Color fundus image
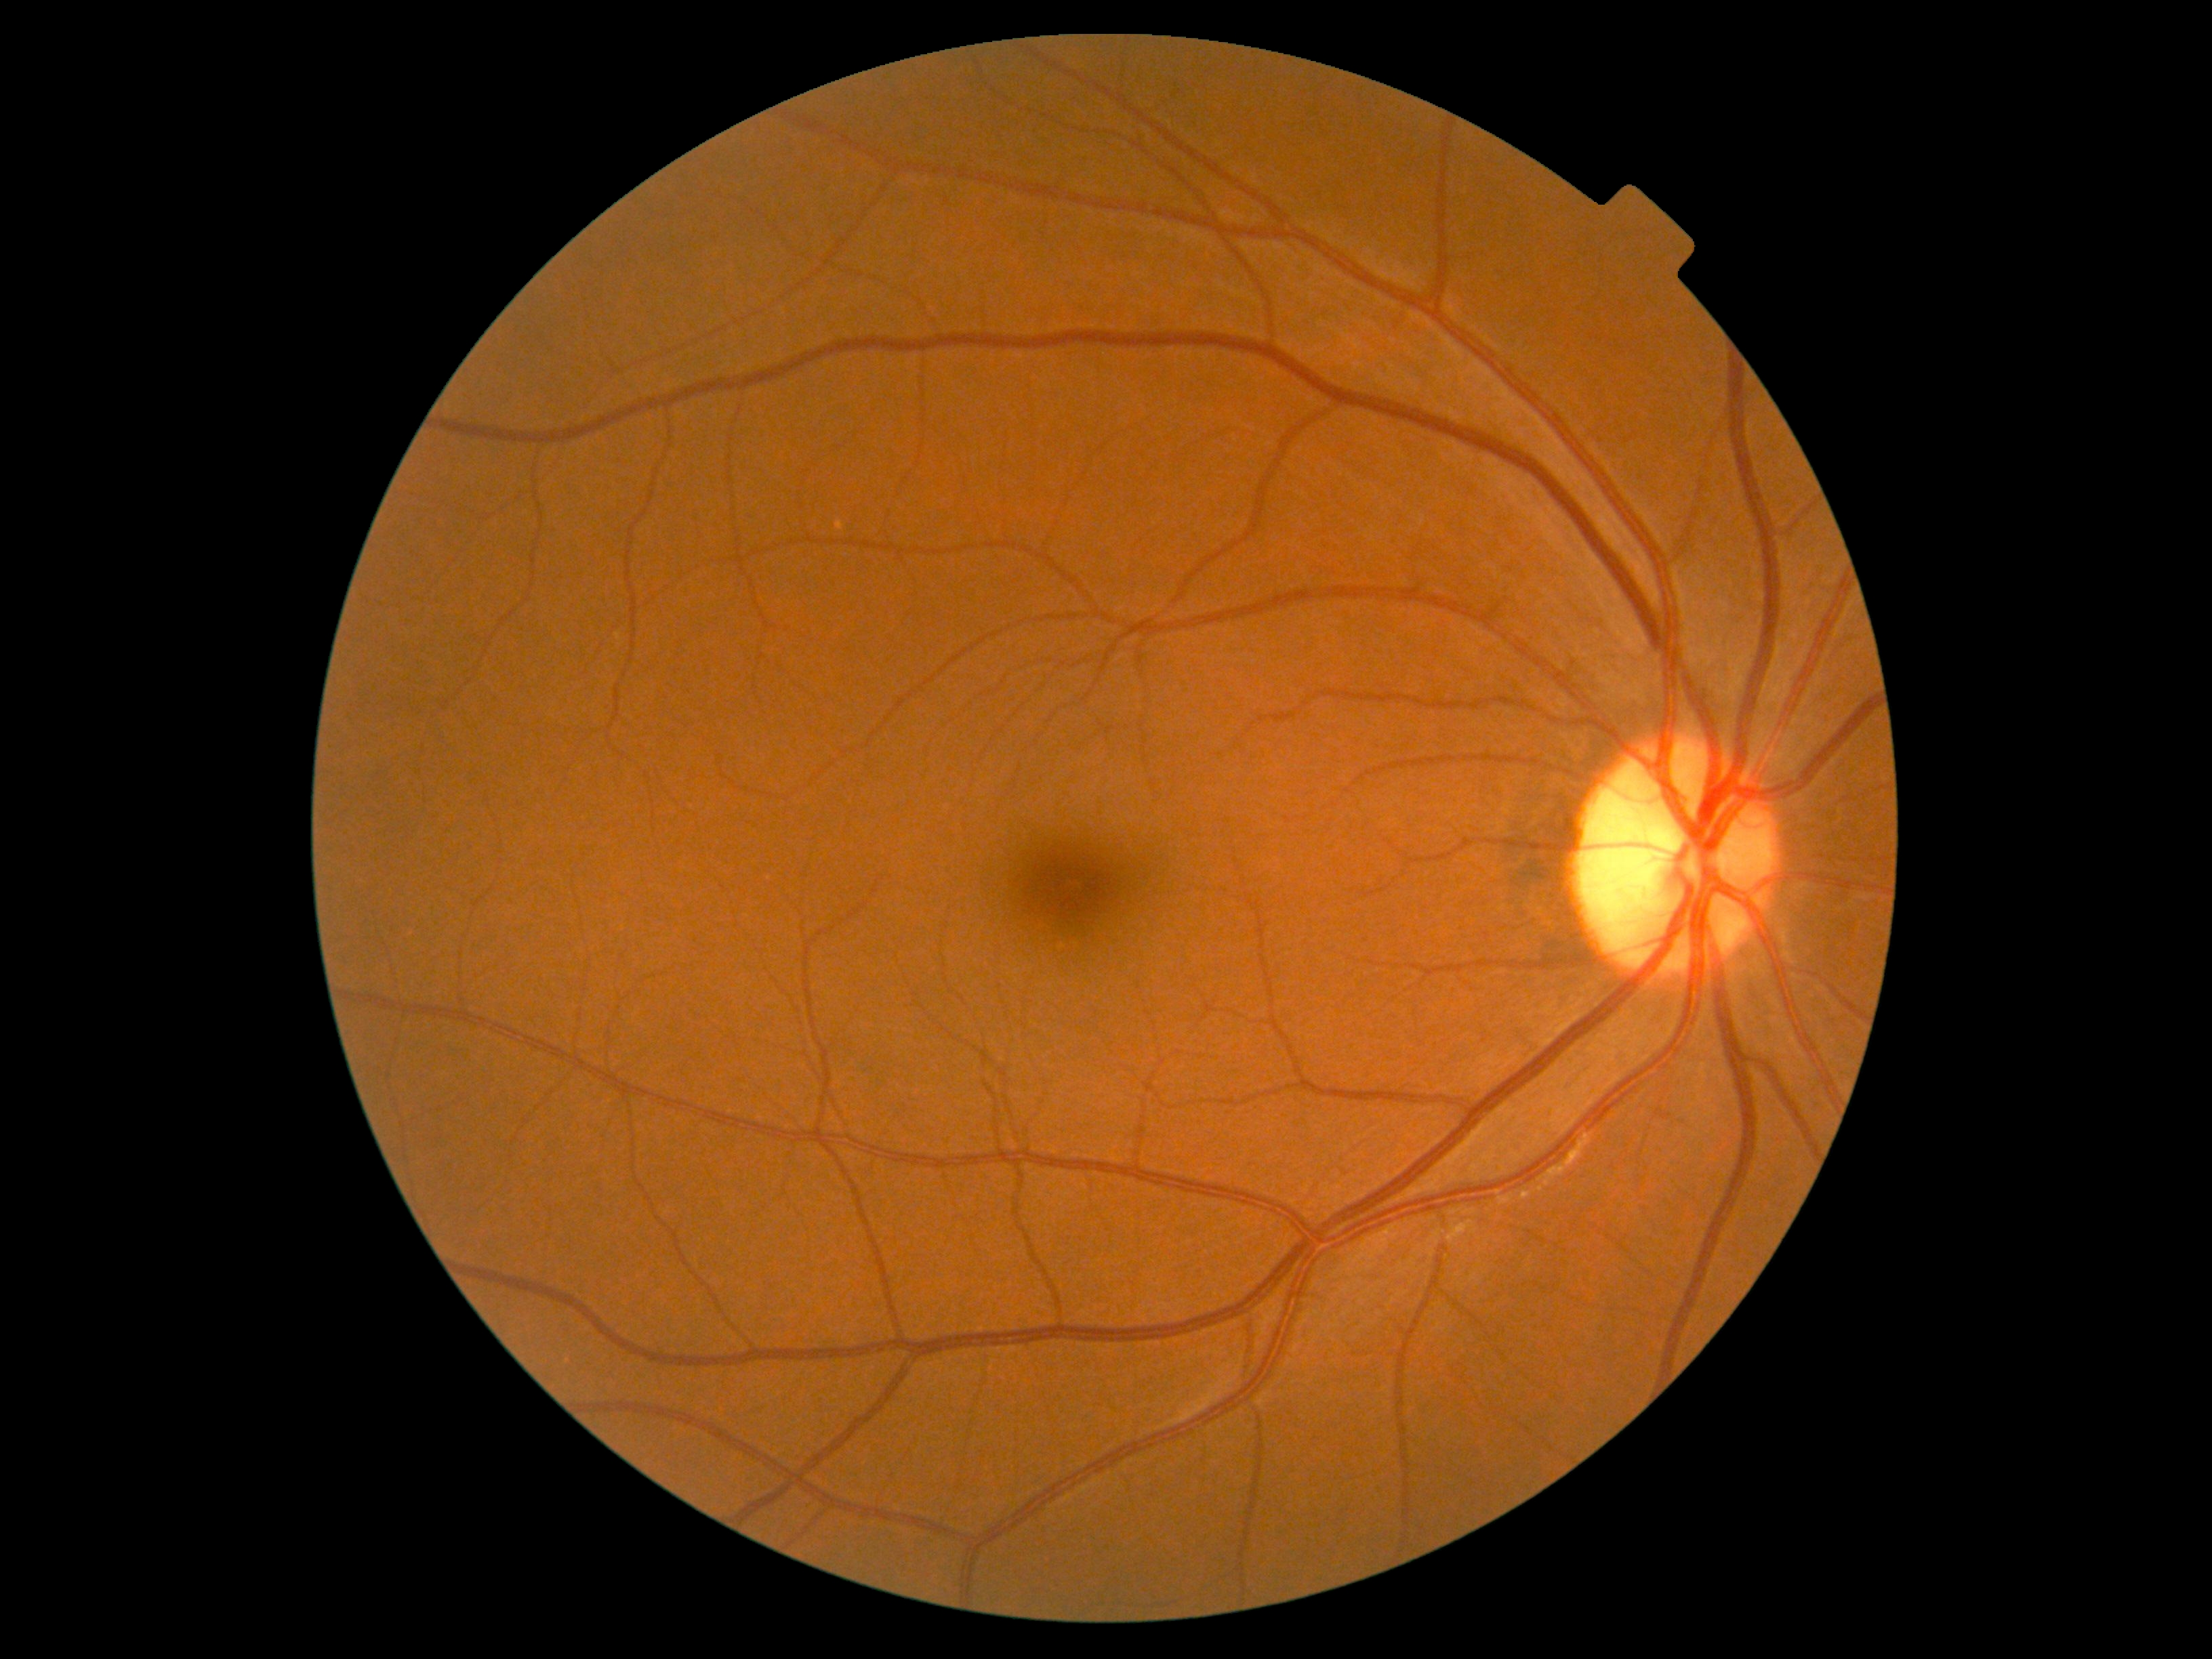

DR impression: no signs of DR, DR: 0.